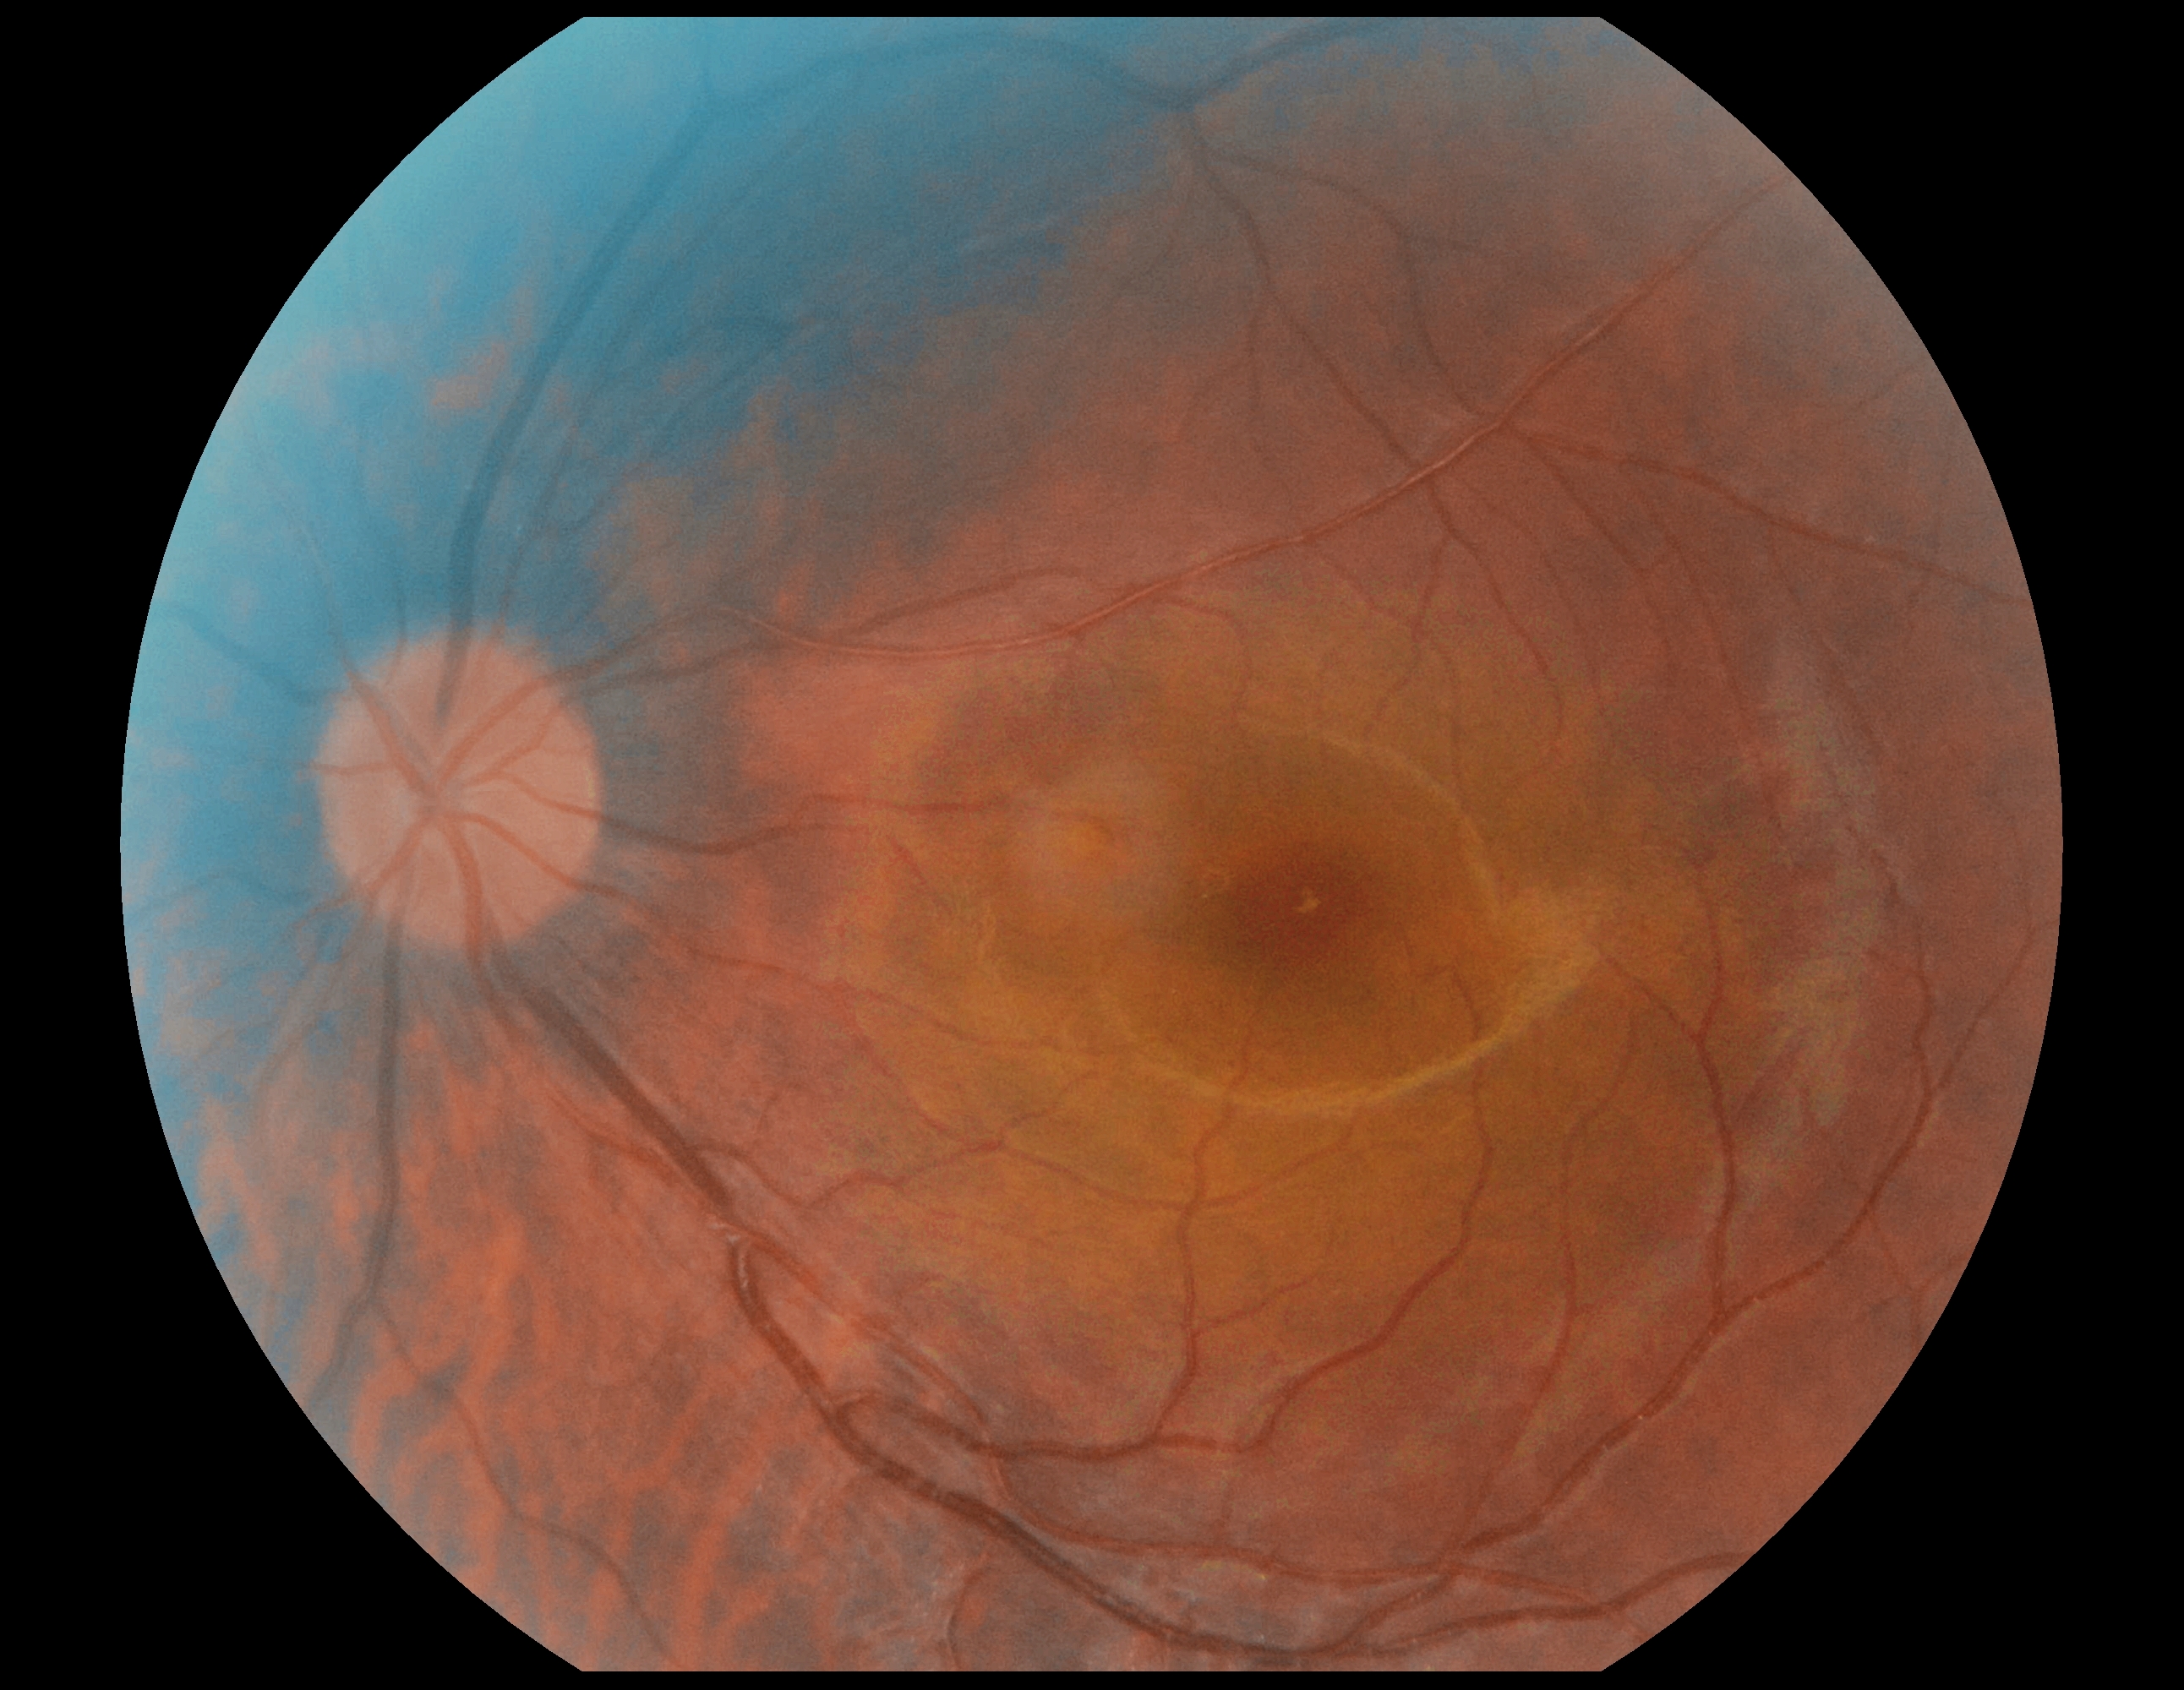
No DR findings. Diabetic retinopathy (DR) is grade 0 (no apparent retinopathy).